Graded on the modified Davis scale.
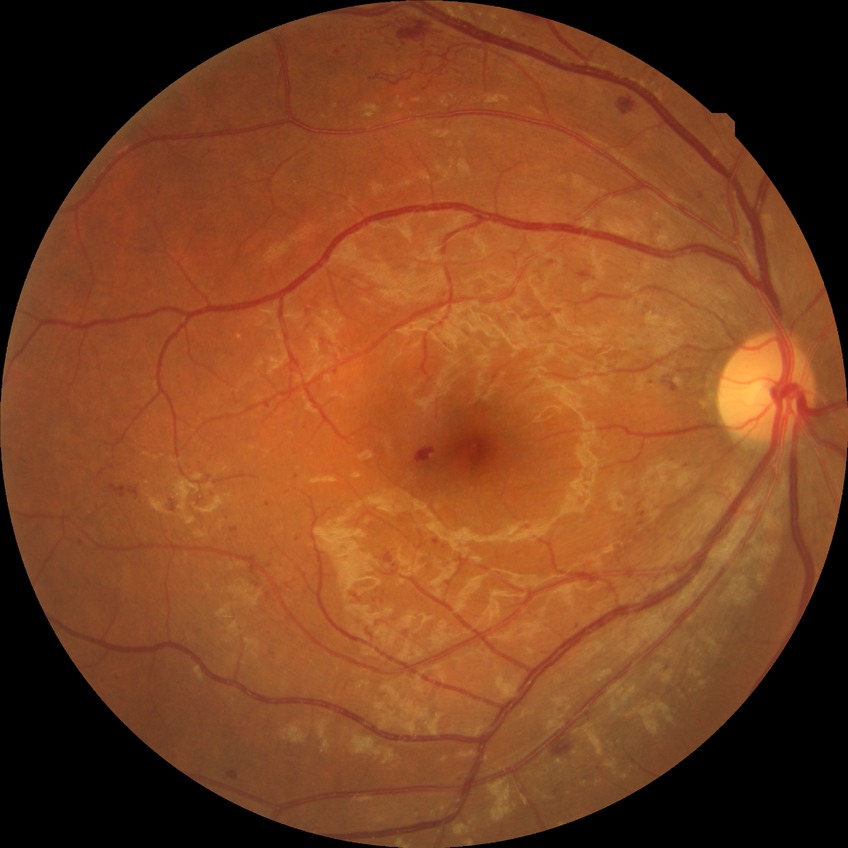 Diabetic retinopathy (DR) is proliferative diabetic retinopathy (PDR).